Image size 2048x1536
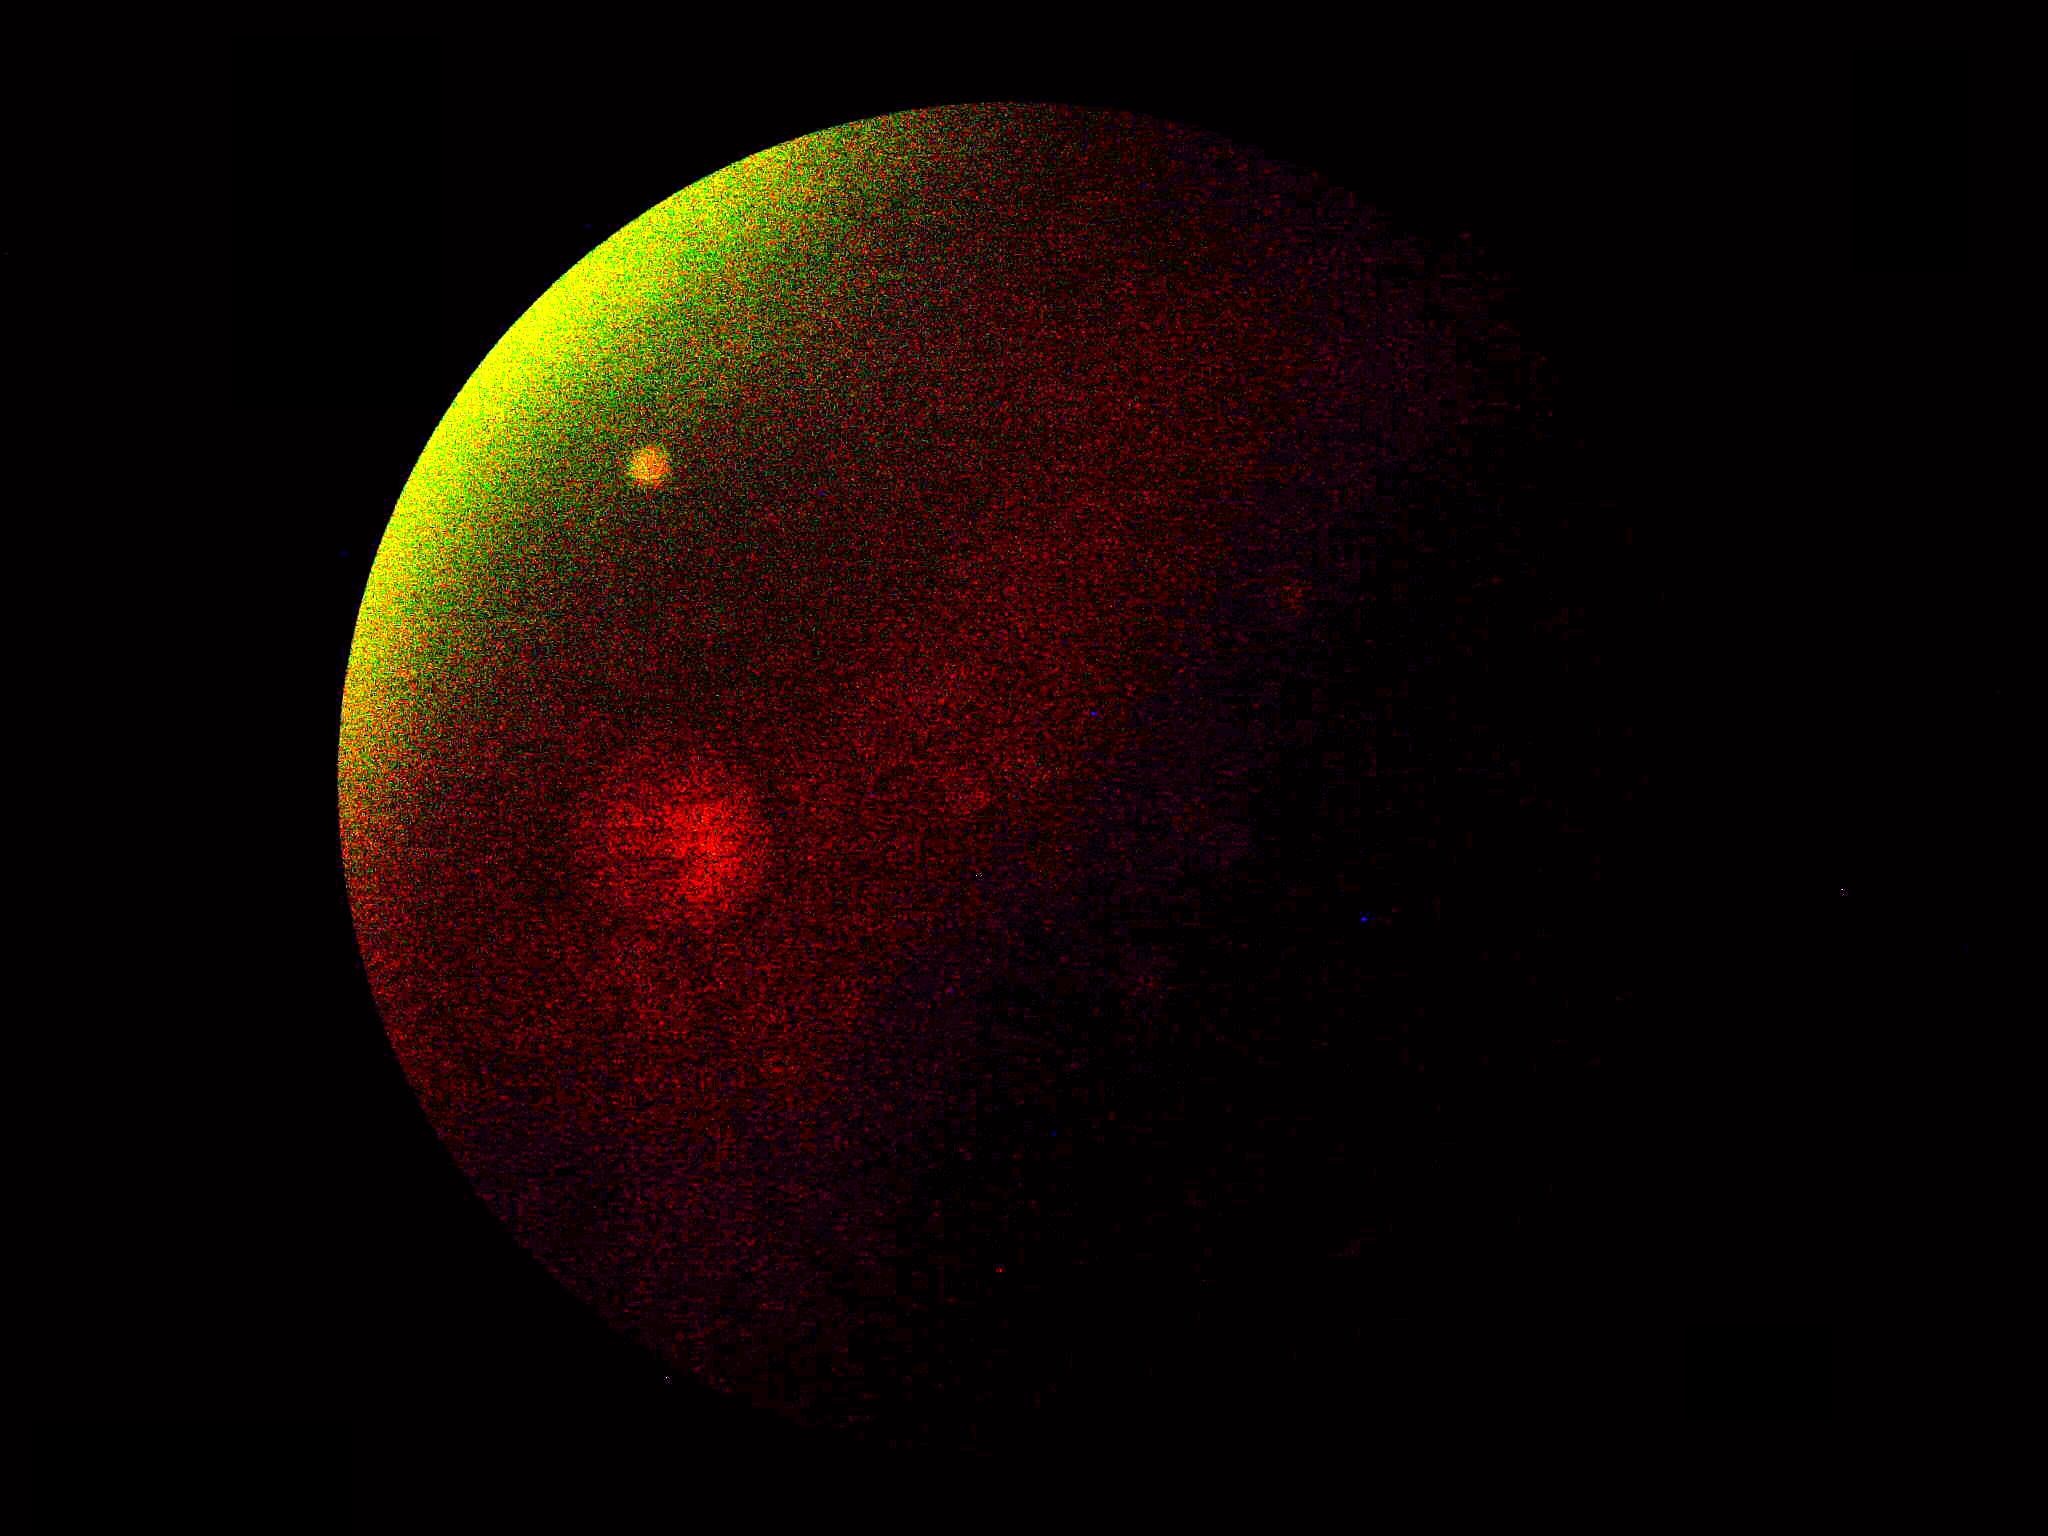
DR grade is ungradable due to poor image quality.